45° field of view: 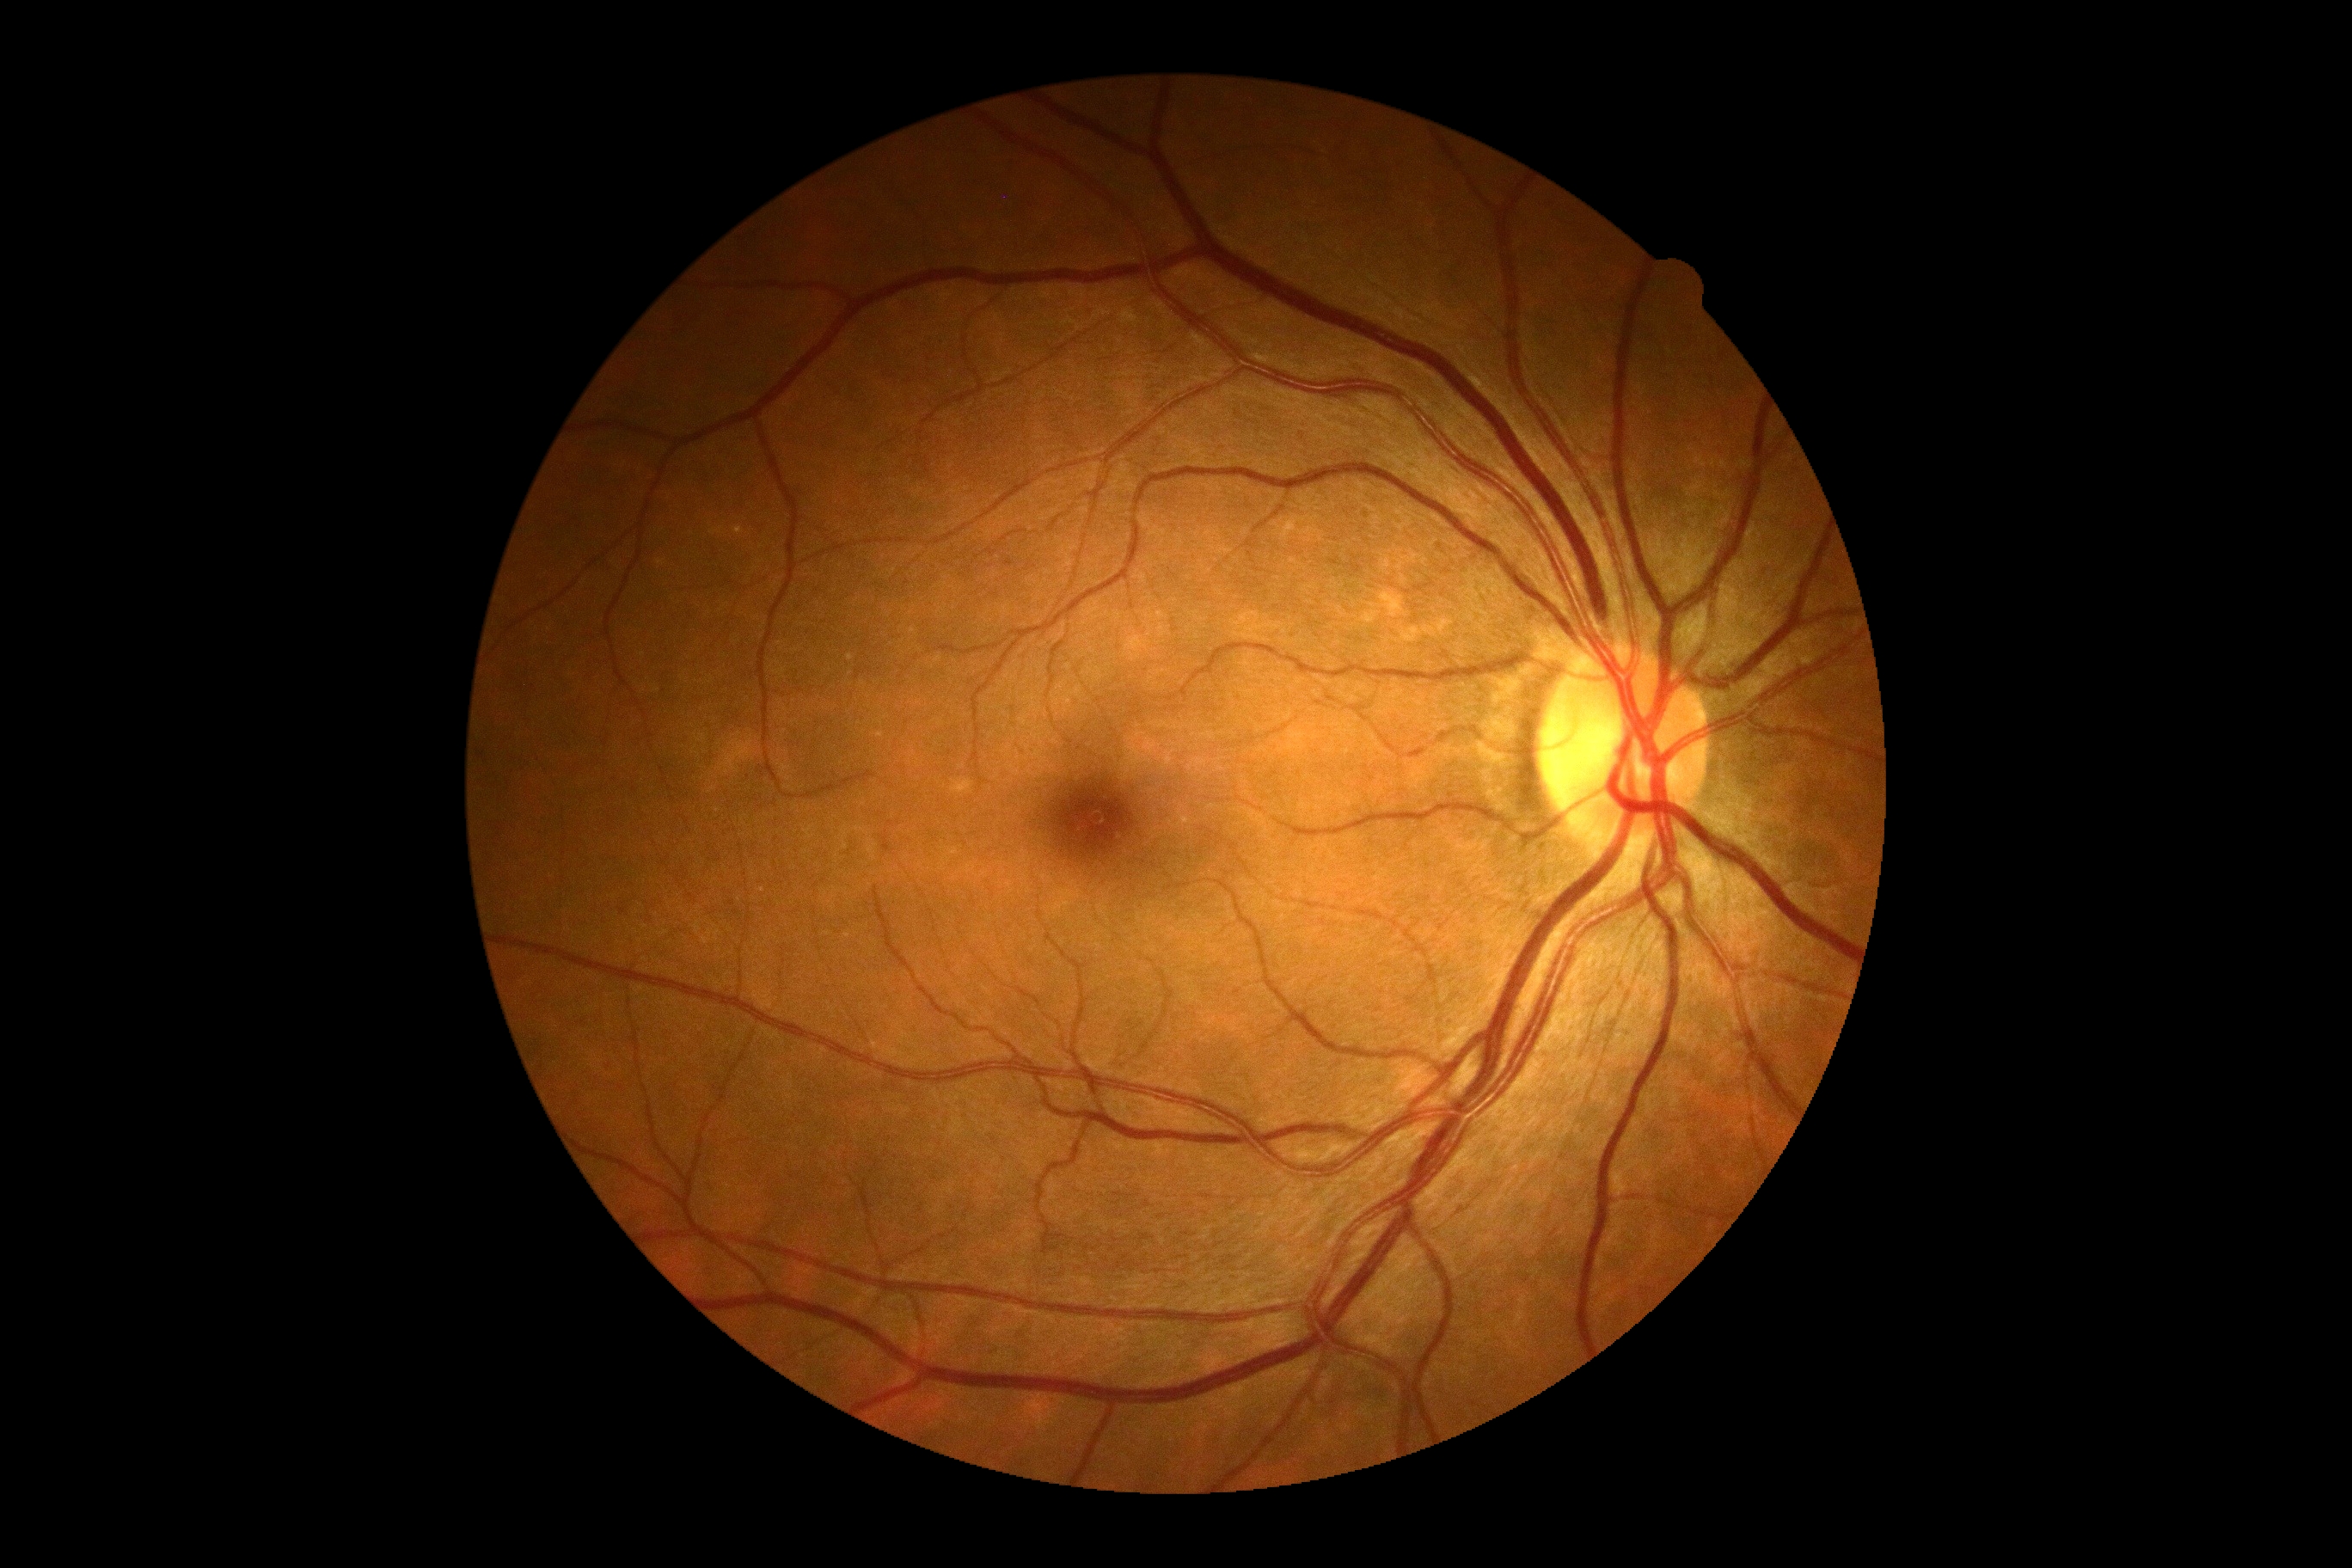 {"dr_impression": "negative for DR", "dr_grade": "no apparent diabetic retinopathy (grade 0)"}